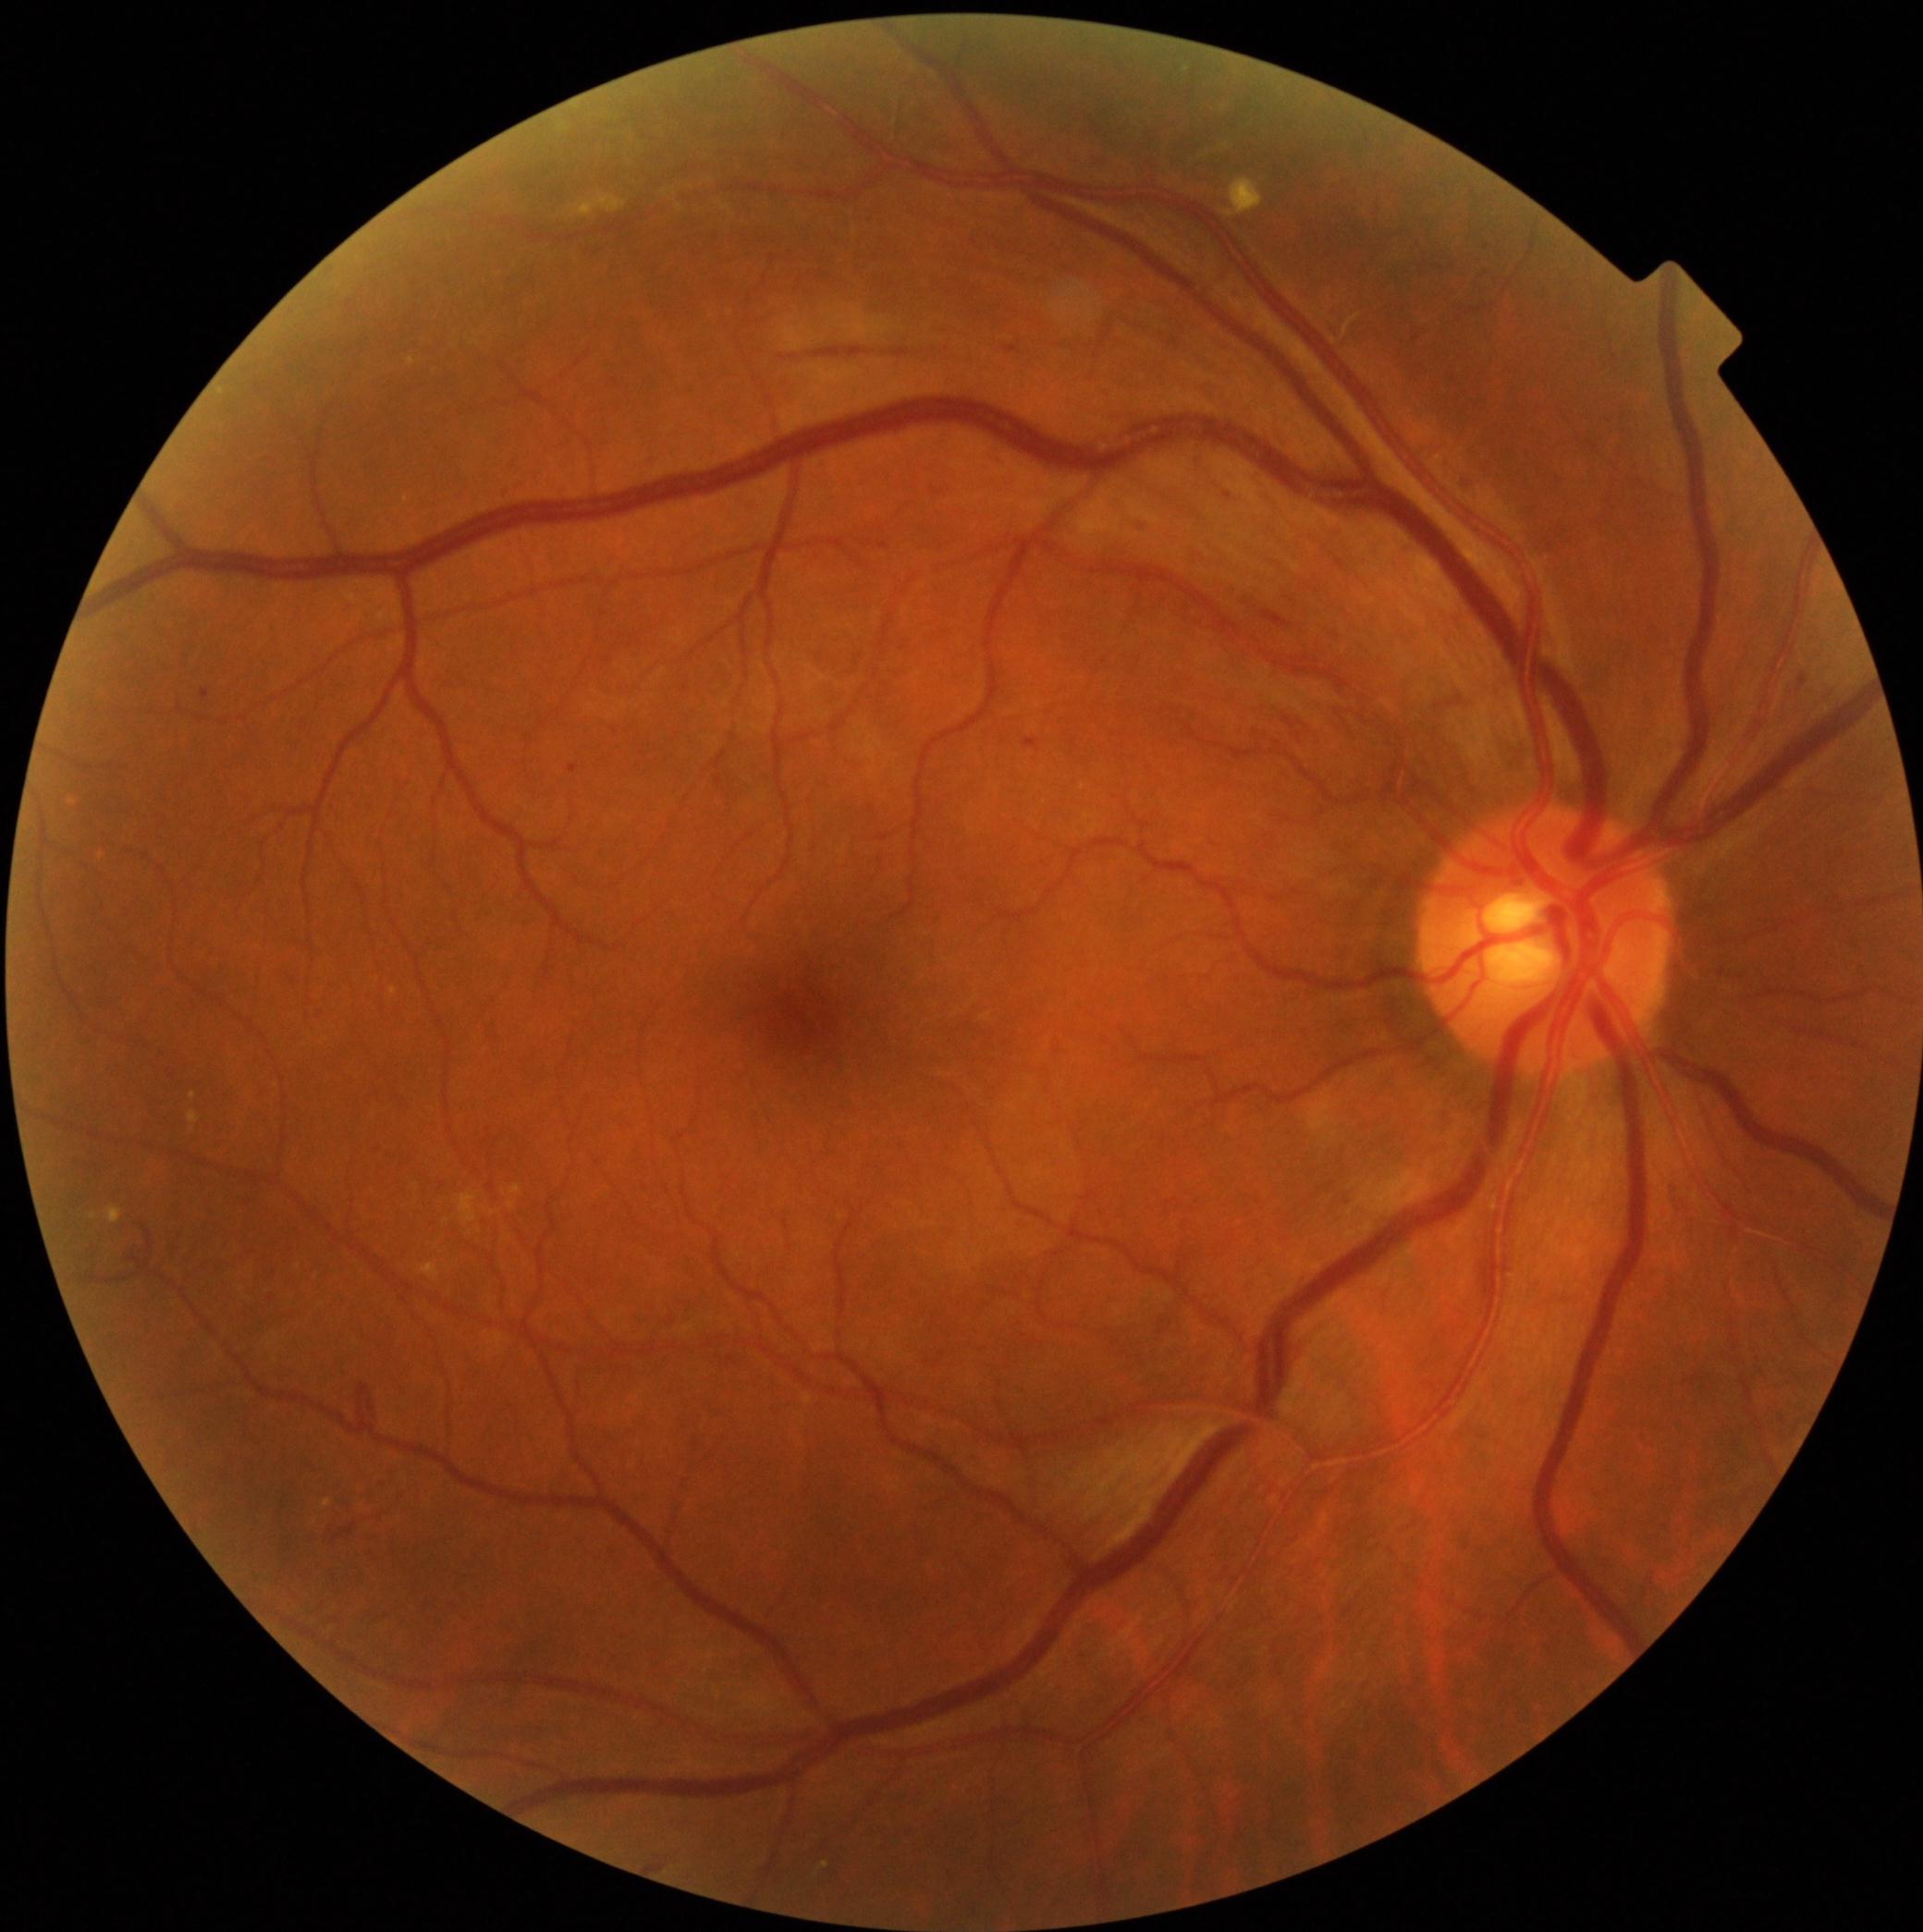 <lesions partial="true">
  <dr_grade>2</dr_grade>
  <ex><bbox>1224, 178, 1265, 218</bbox>; <bbox>821, 1862, 830, 1869</bbox>; <bbox>570, 194, 626, 218</bbox>; <bbox>107, 1206, 123, 1225</bbox></ex>
  <ex_small_centers>(x=412, y=362); (x=476, y=343)</ex_small_centers>
  <he partial="true"><bbox>1023, 740, 1038, 750</bbox>; <bbox>770, 348, 978, 375</bbox>; <bbox>1005, 347, 1018, 355</bbox>; <bbox>1690, 1369, 1718, 1405</bbox>; <bbox>1452, 465, 1478, 505</bbox>; <bbox>1710, 965, 1750, 985</bbox>; <bbox>1800, 677, 1807, 688</bbox>; <bbox>257, 1084, 273, 1100</bbox>; <bbox>1670, 1184, 1699, 1244</bbox>; <bbox>366, 1144, 388, 1158</bbox></he>
  <se />
  <ma><bbox>570, 764, 580, 774</bbox>; <bbox>1188, 542, 1208, 567</bbox>; <bbox>202, 690, 211, 699</bbox>; <bbox>1221, 487, 1239, 507</bbox>; <bbox>1085, 158, 1119, 169</bbox>; <bbox>1133, 518, 1151, 536</bbox>; <bbox>1241, 585, 1291, 630</bbox></ma>
</lesions>